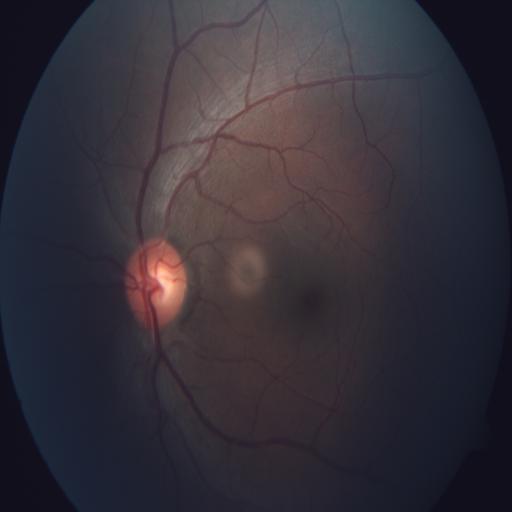
Unremarkable color fundus photograph.